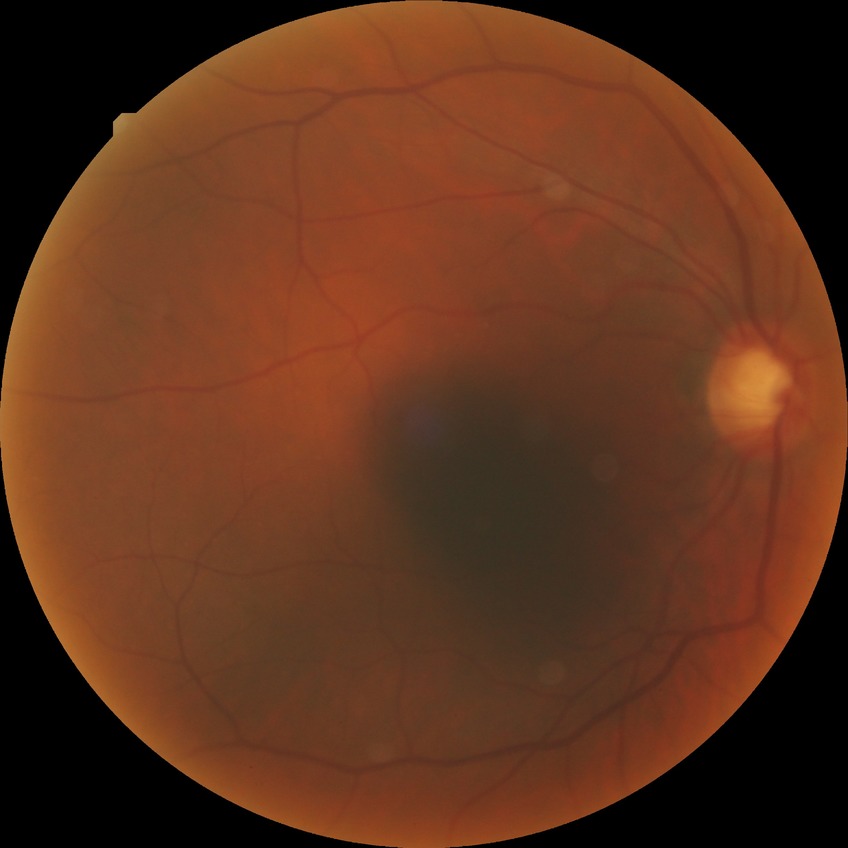 Diabetic retinopathy (DR) is NDR (no diabetic retinopathy).